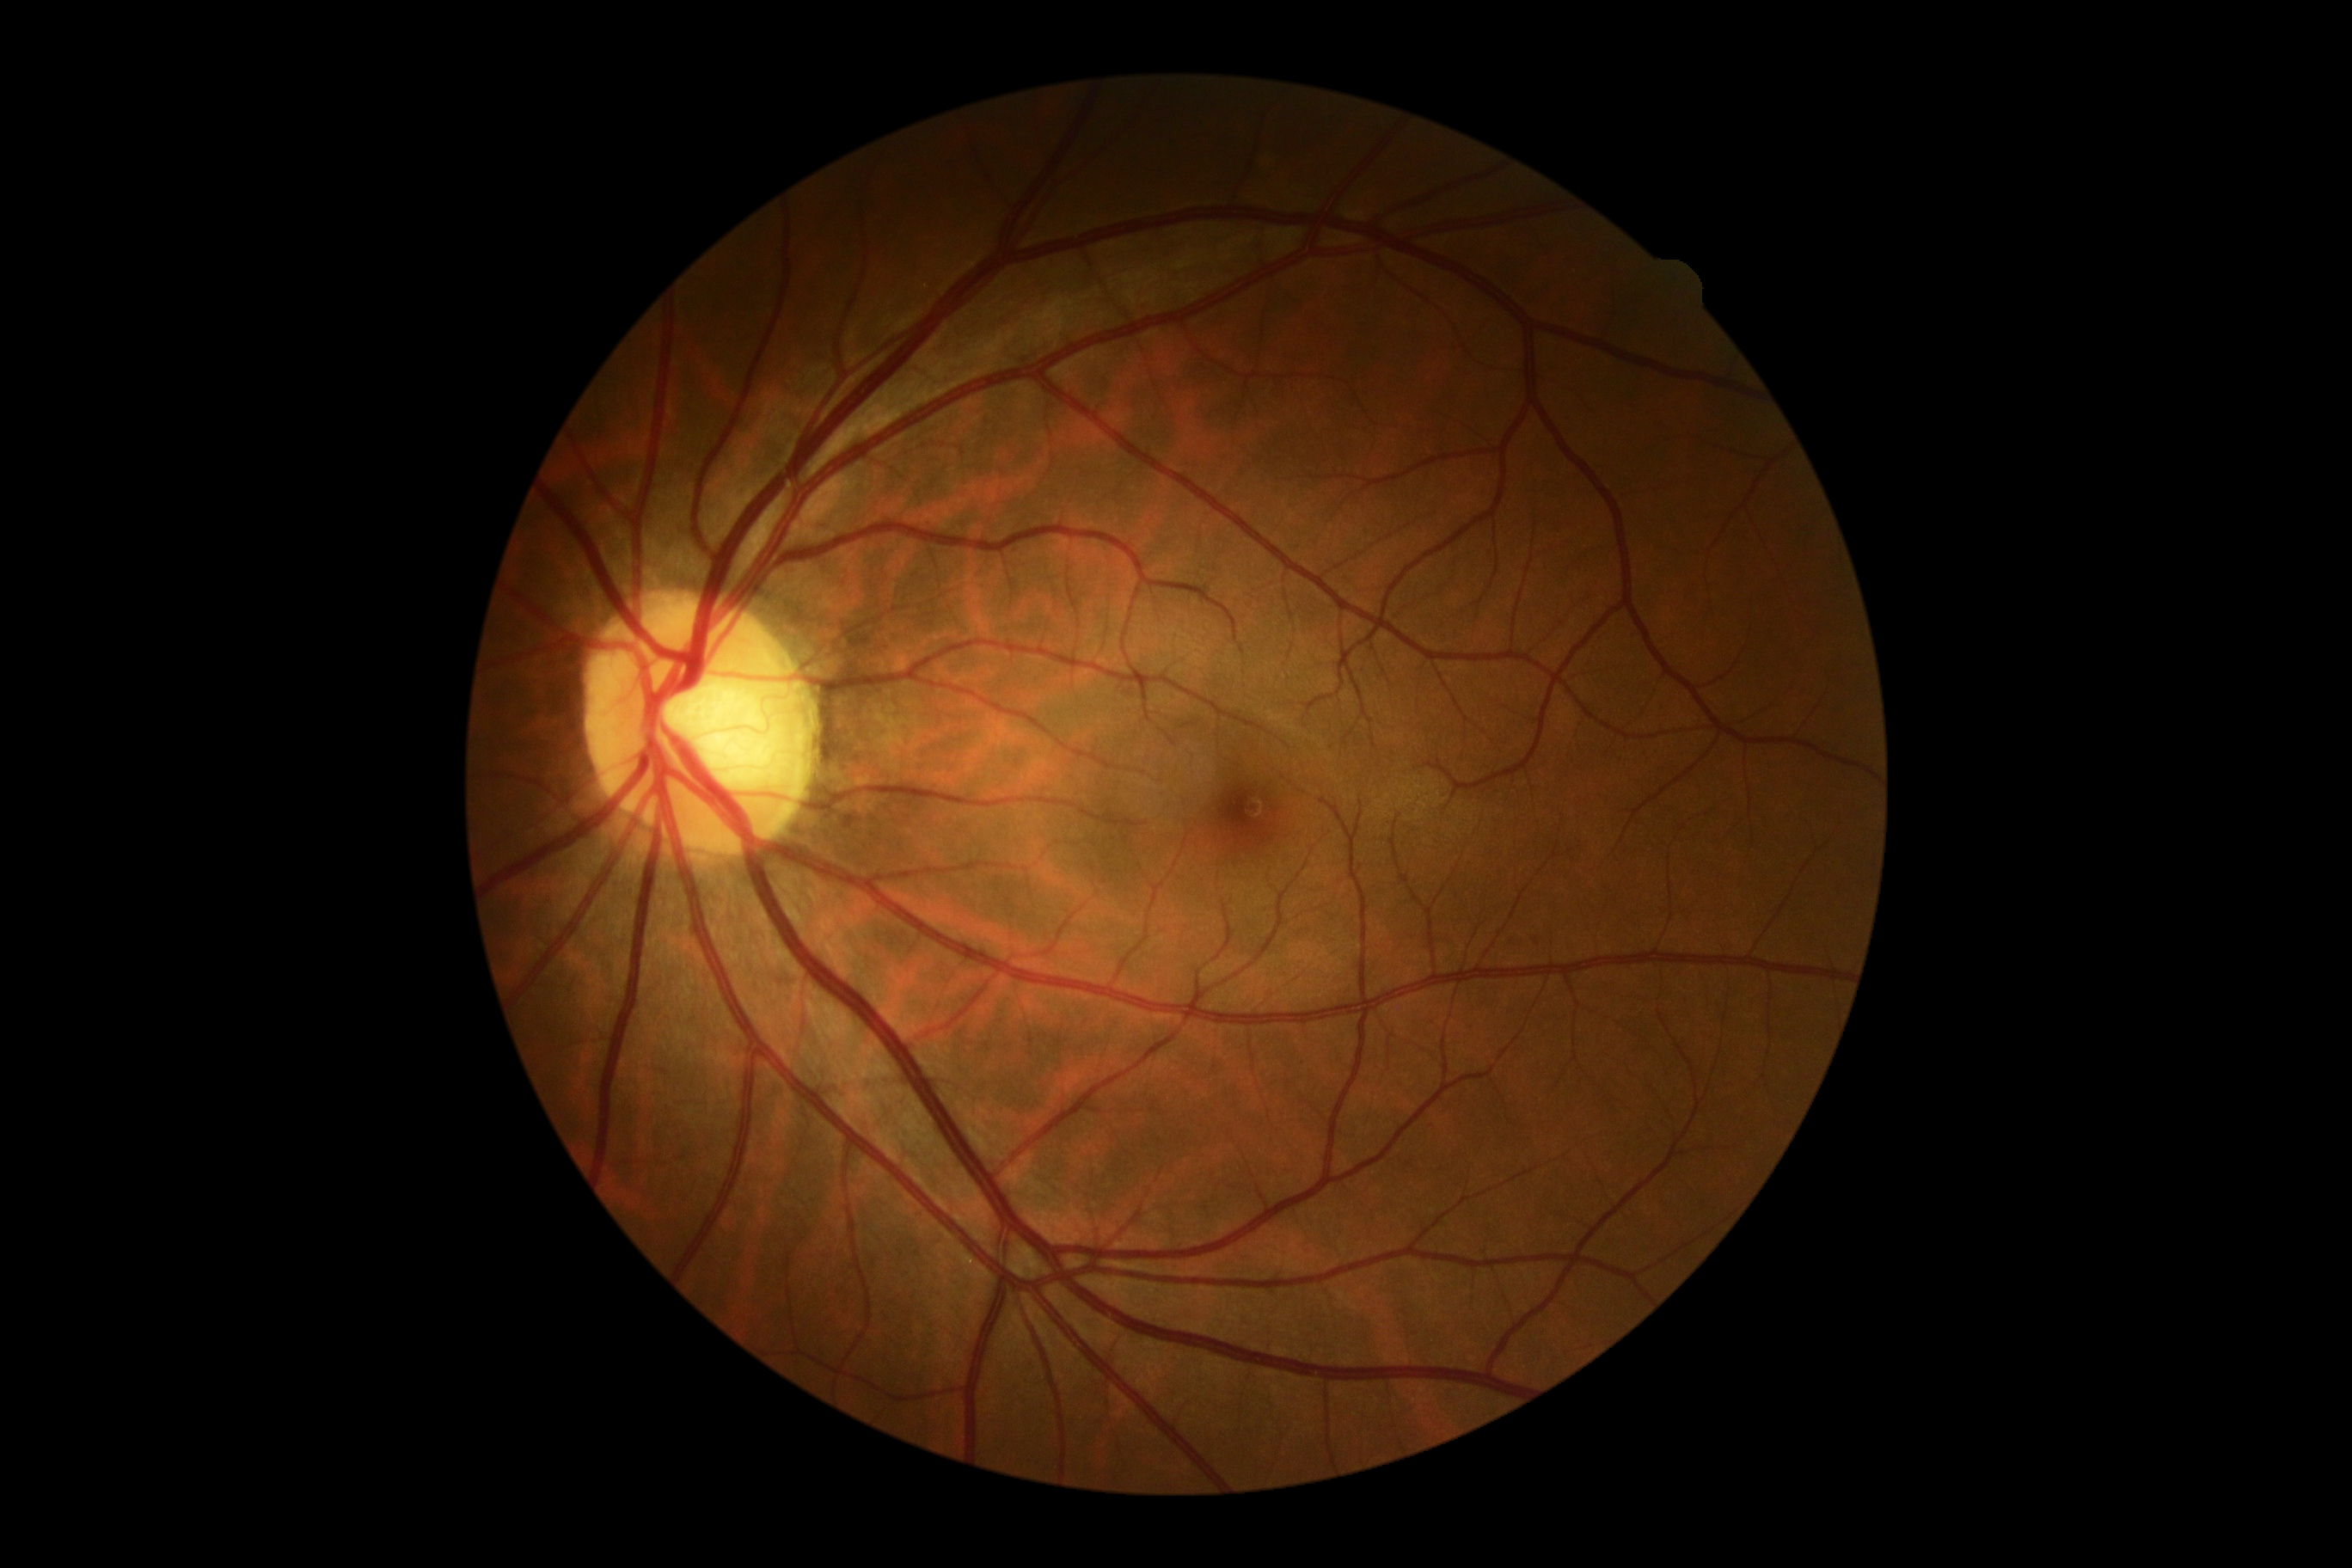

Diabetic retinopathy (DR): 0.
No signs of diabetic retinopathy.